Color fundus photograph, 45-degree field of view:
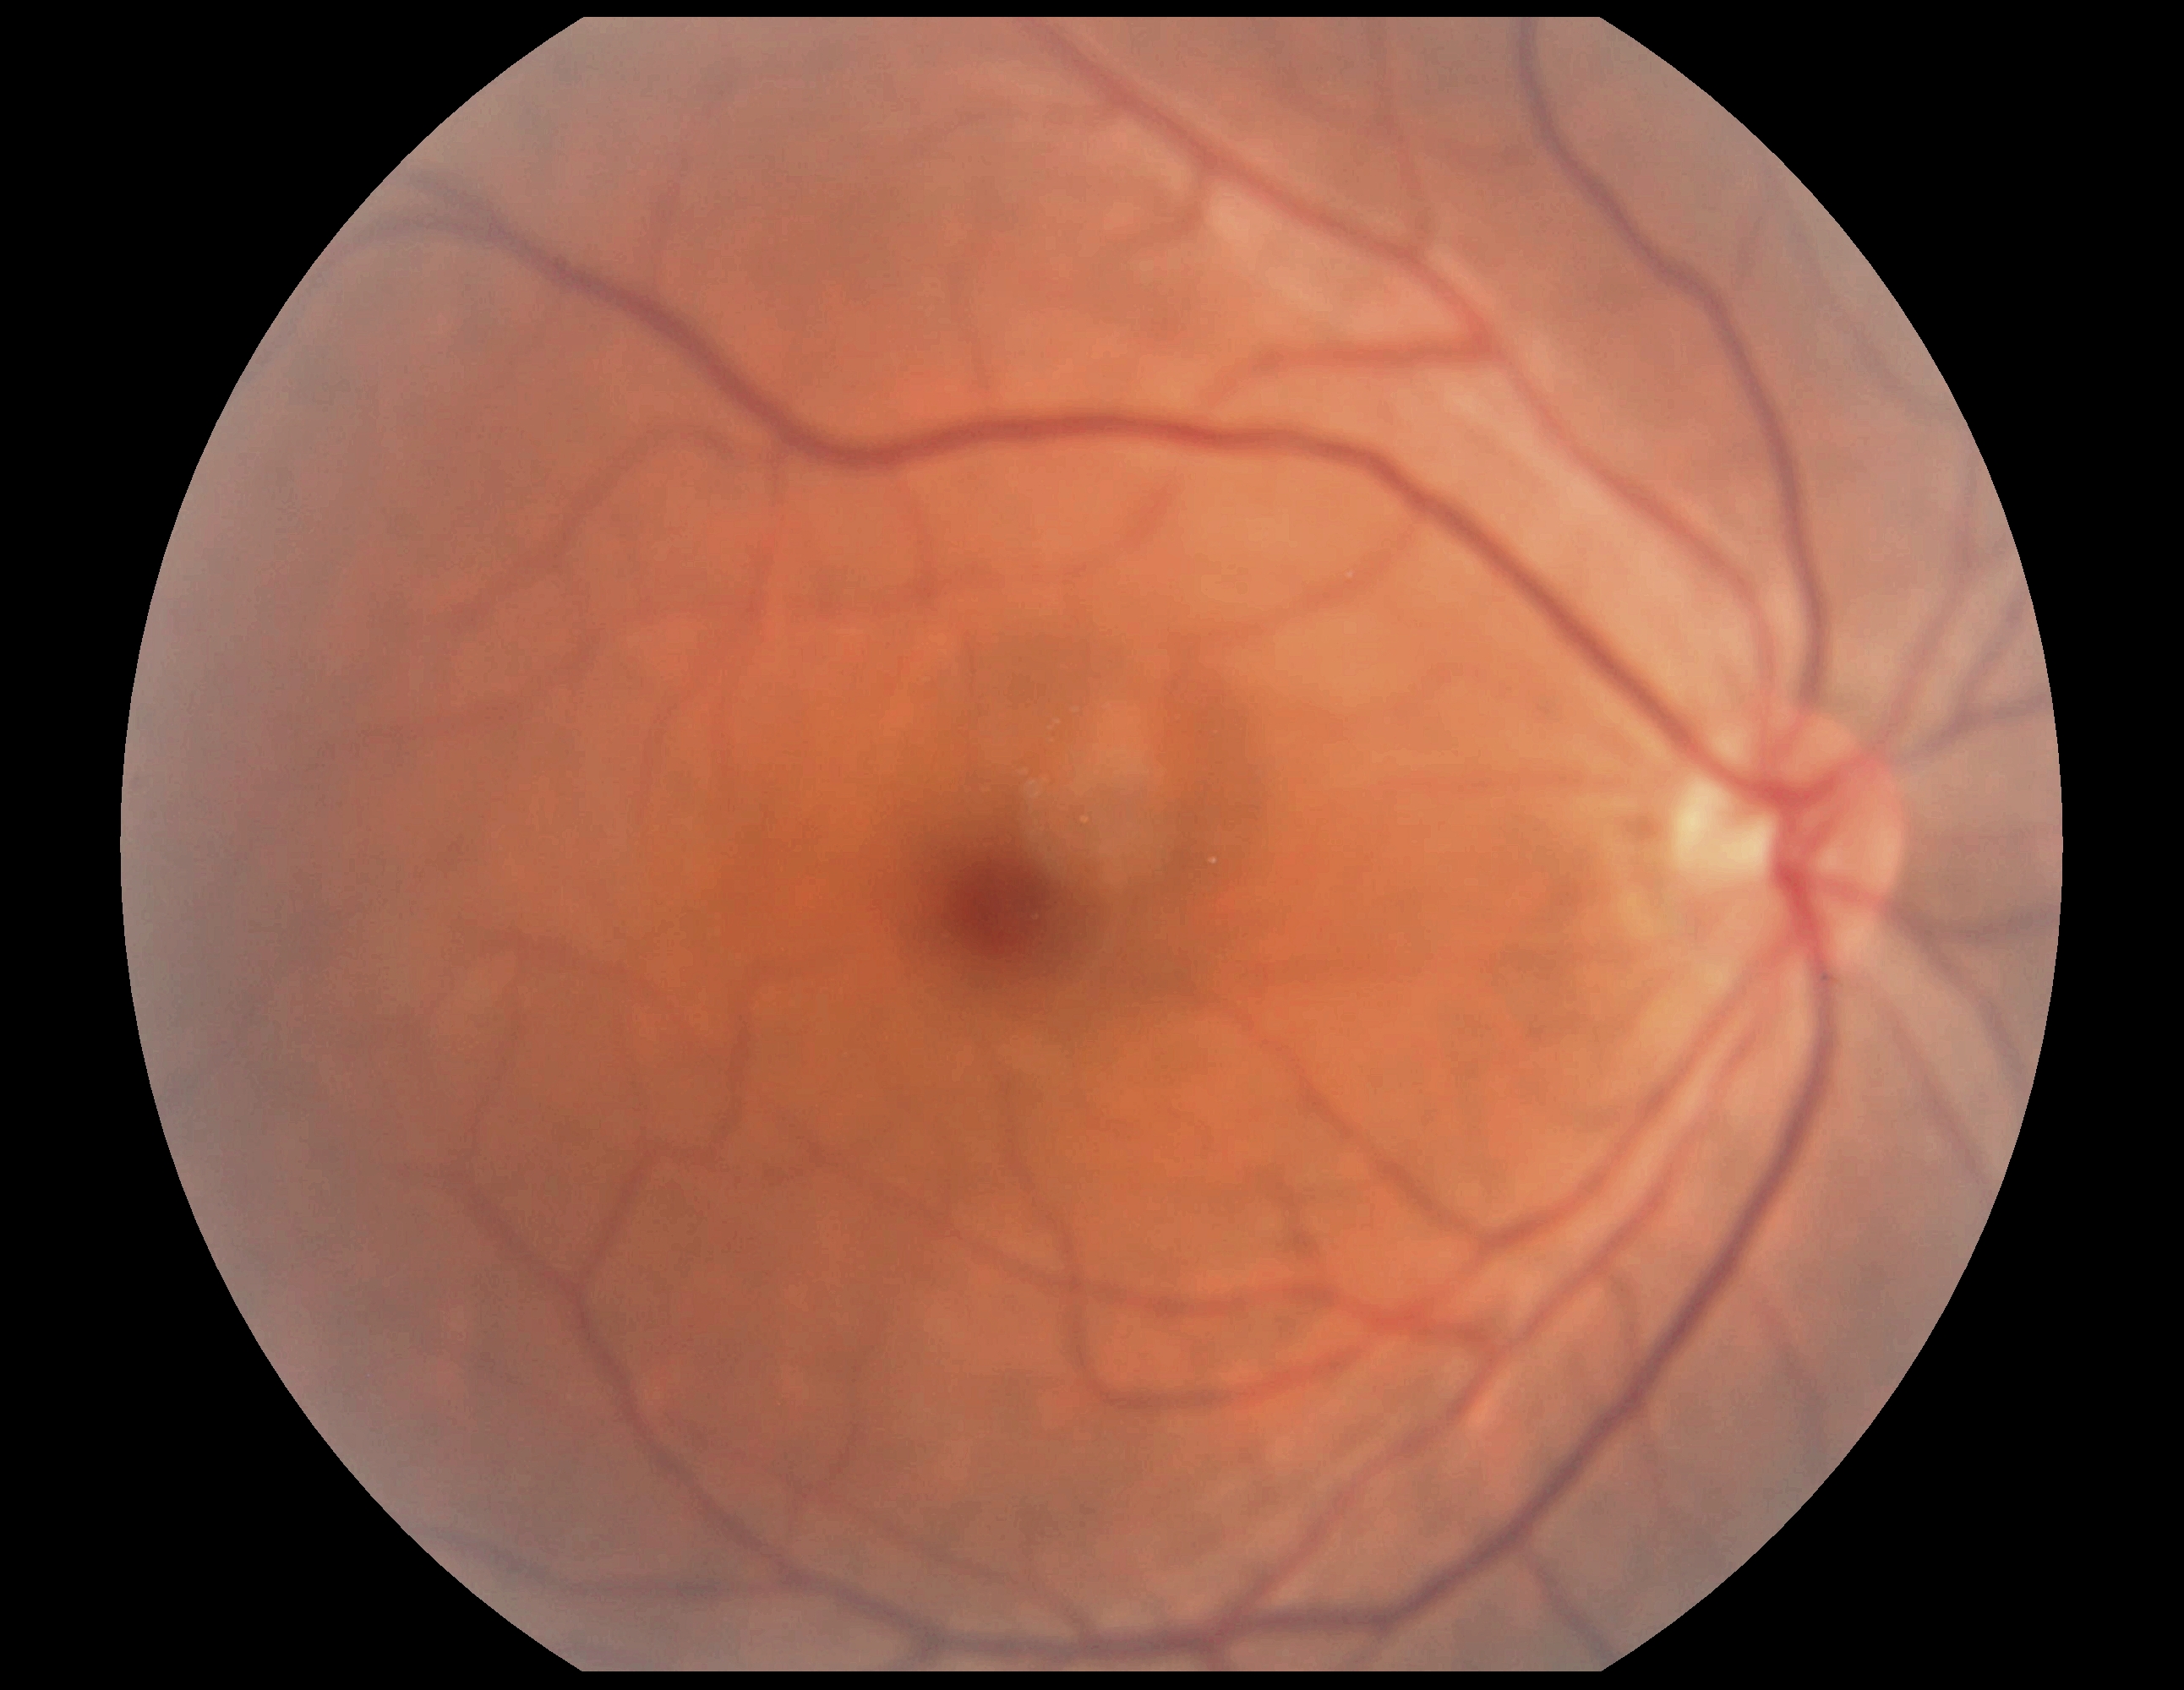

DR impression=negative for DR, DR grade=0.